45° FOV, nonmydriatic fundus photograph, 848 by 848 pixels — 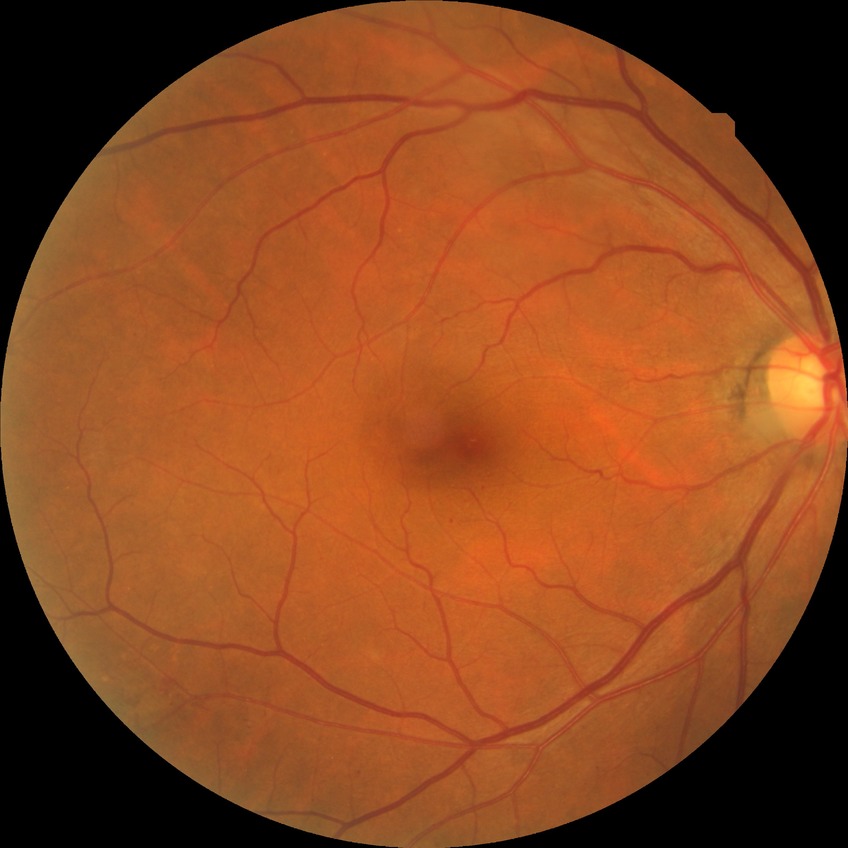

Diabetic retinopathy (DR): NDR (no diabetic retinopathy).